Color fundus image. Captured on a Topcon TRC-50DX fundus camera — 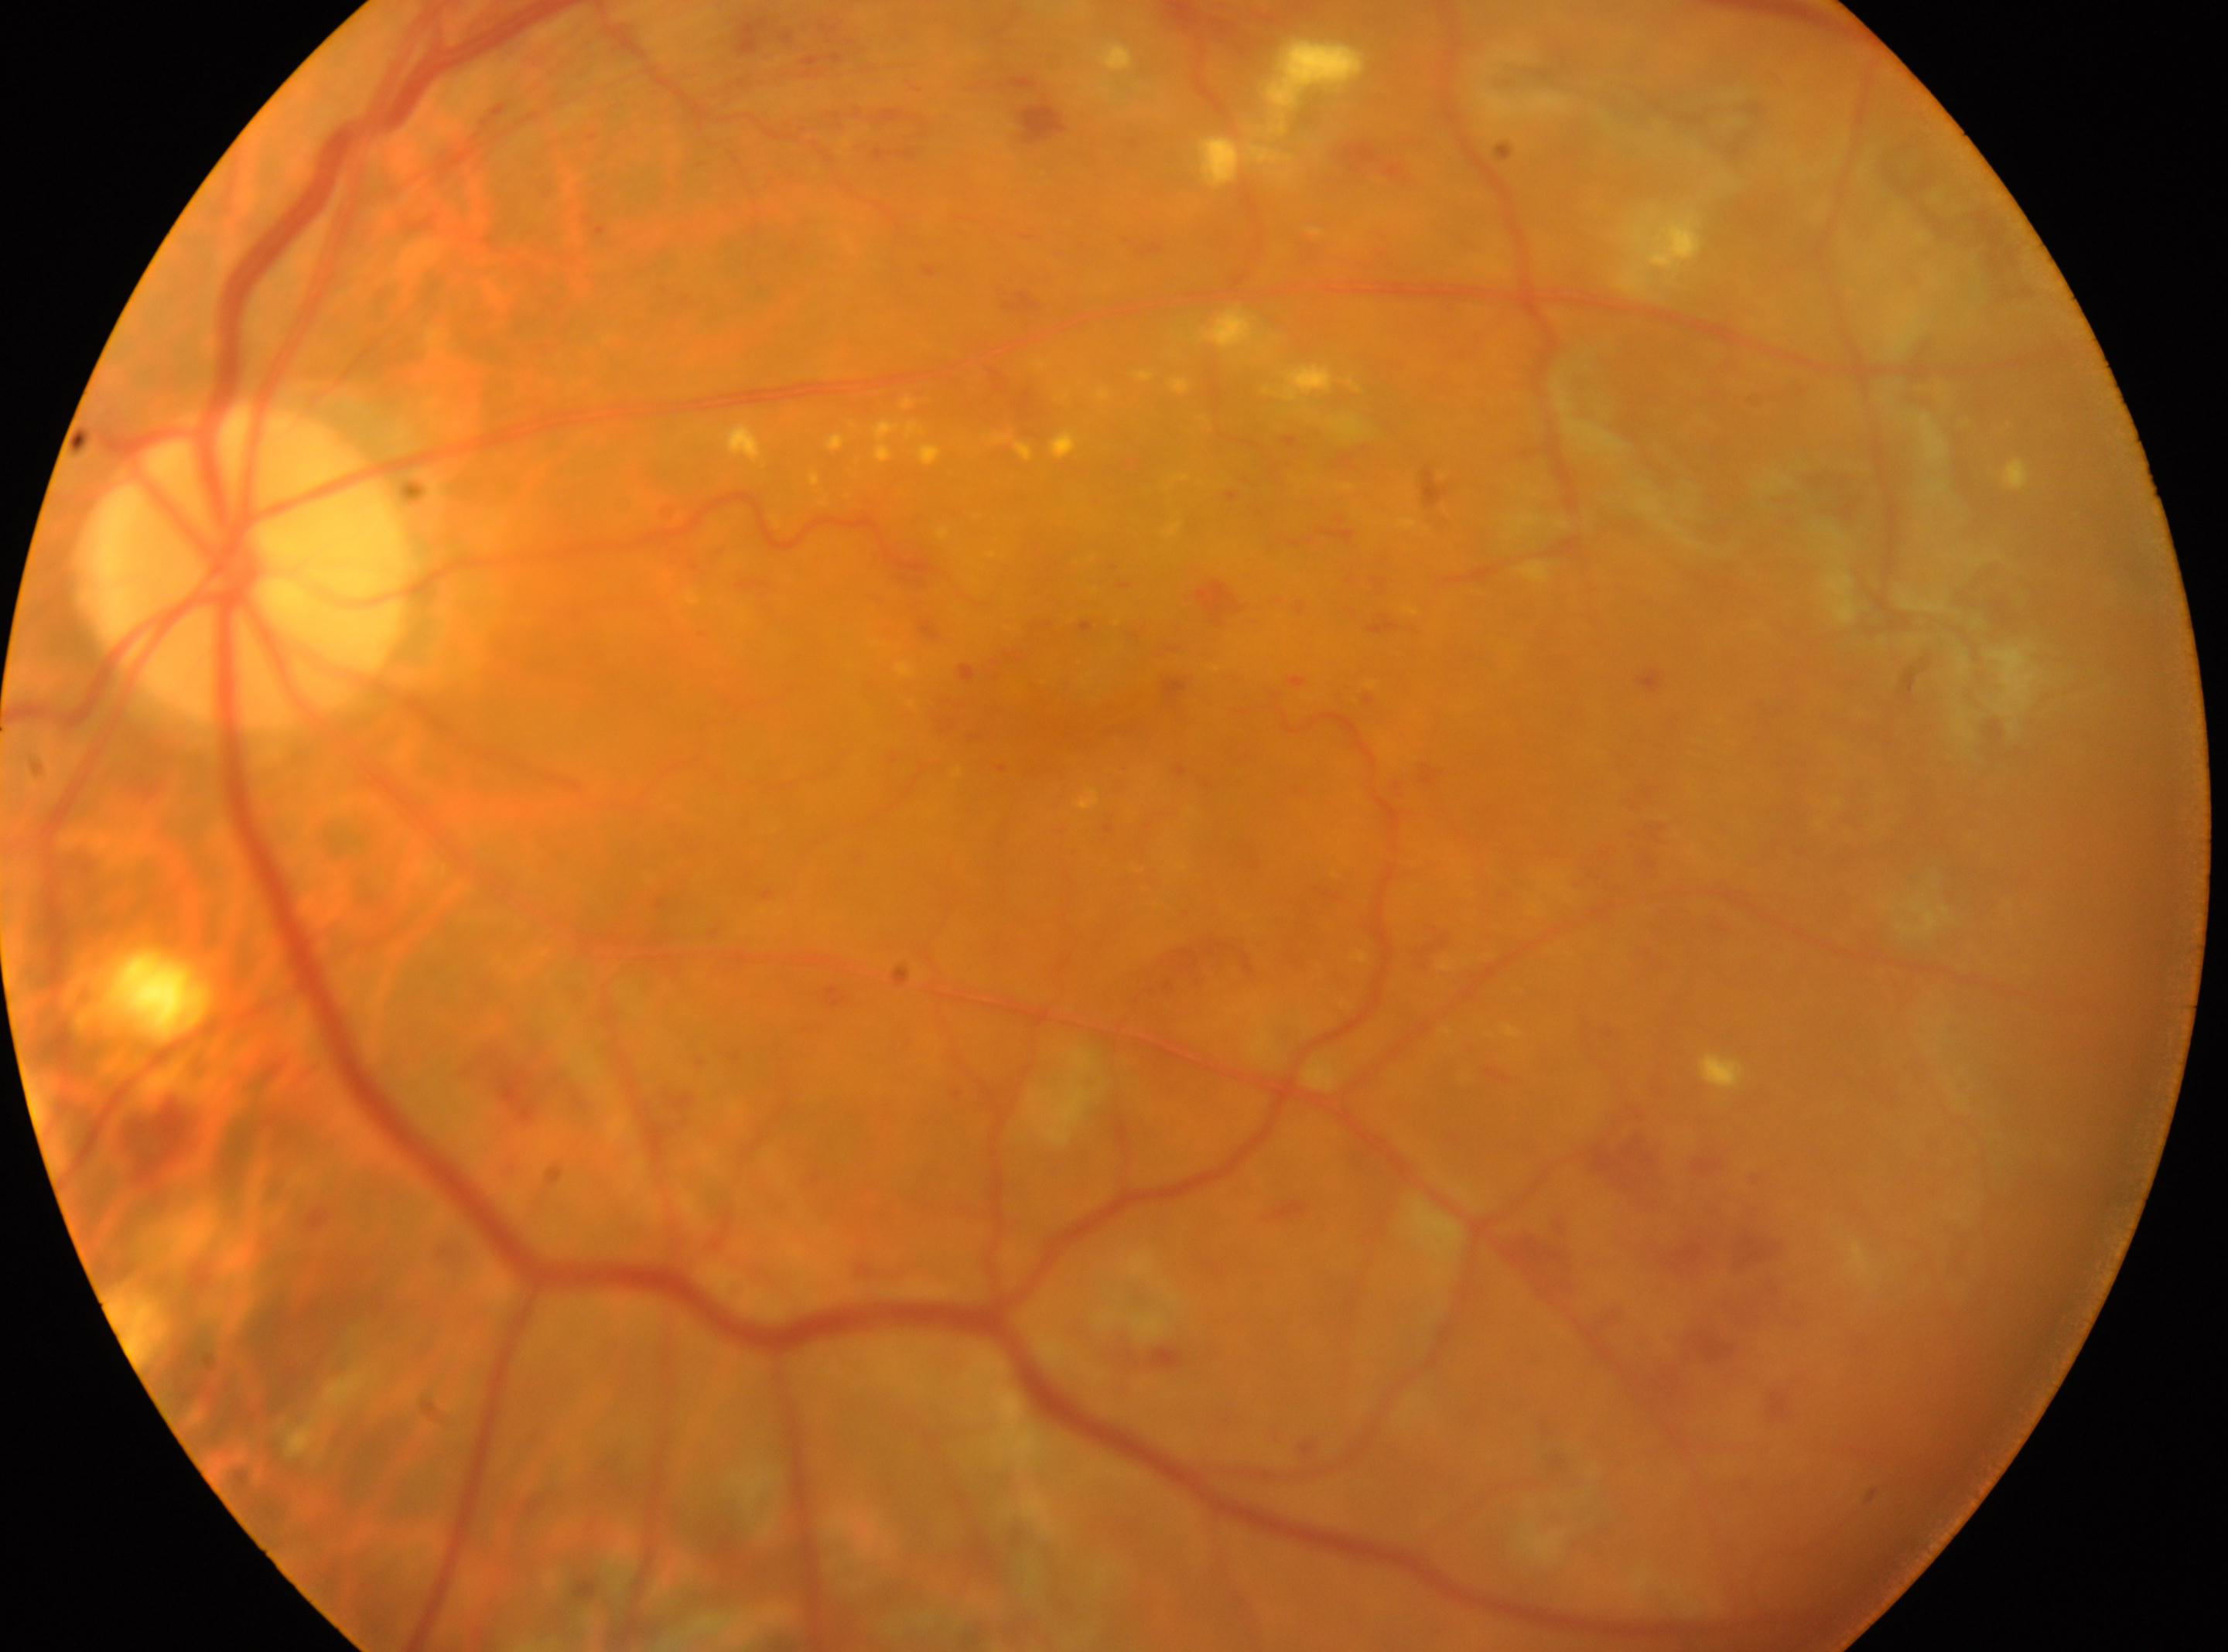
The optic disc is at x=243, y=565.
DR stage is laser-treated DR.
This is the oculus sinister.
Macula center: x=1010, y=708.